Fundus photo: 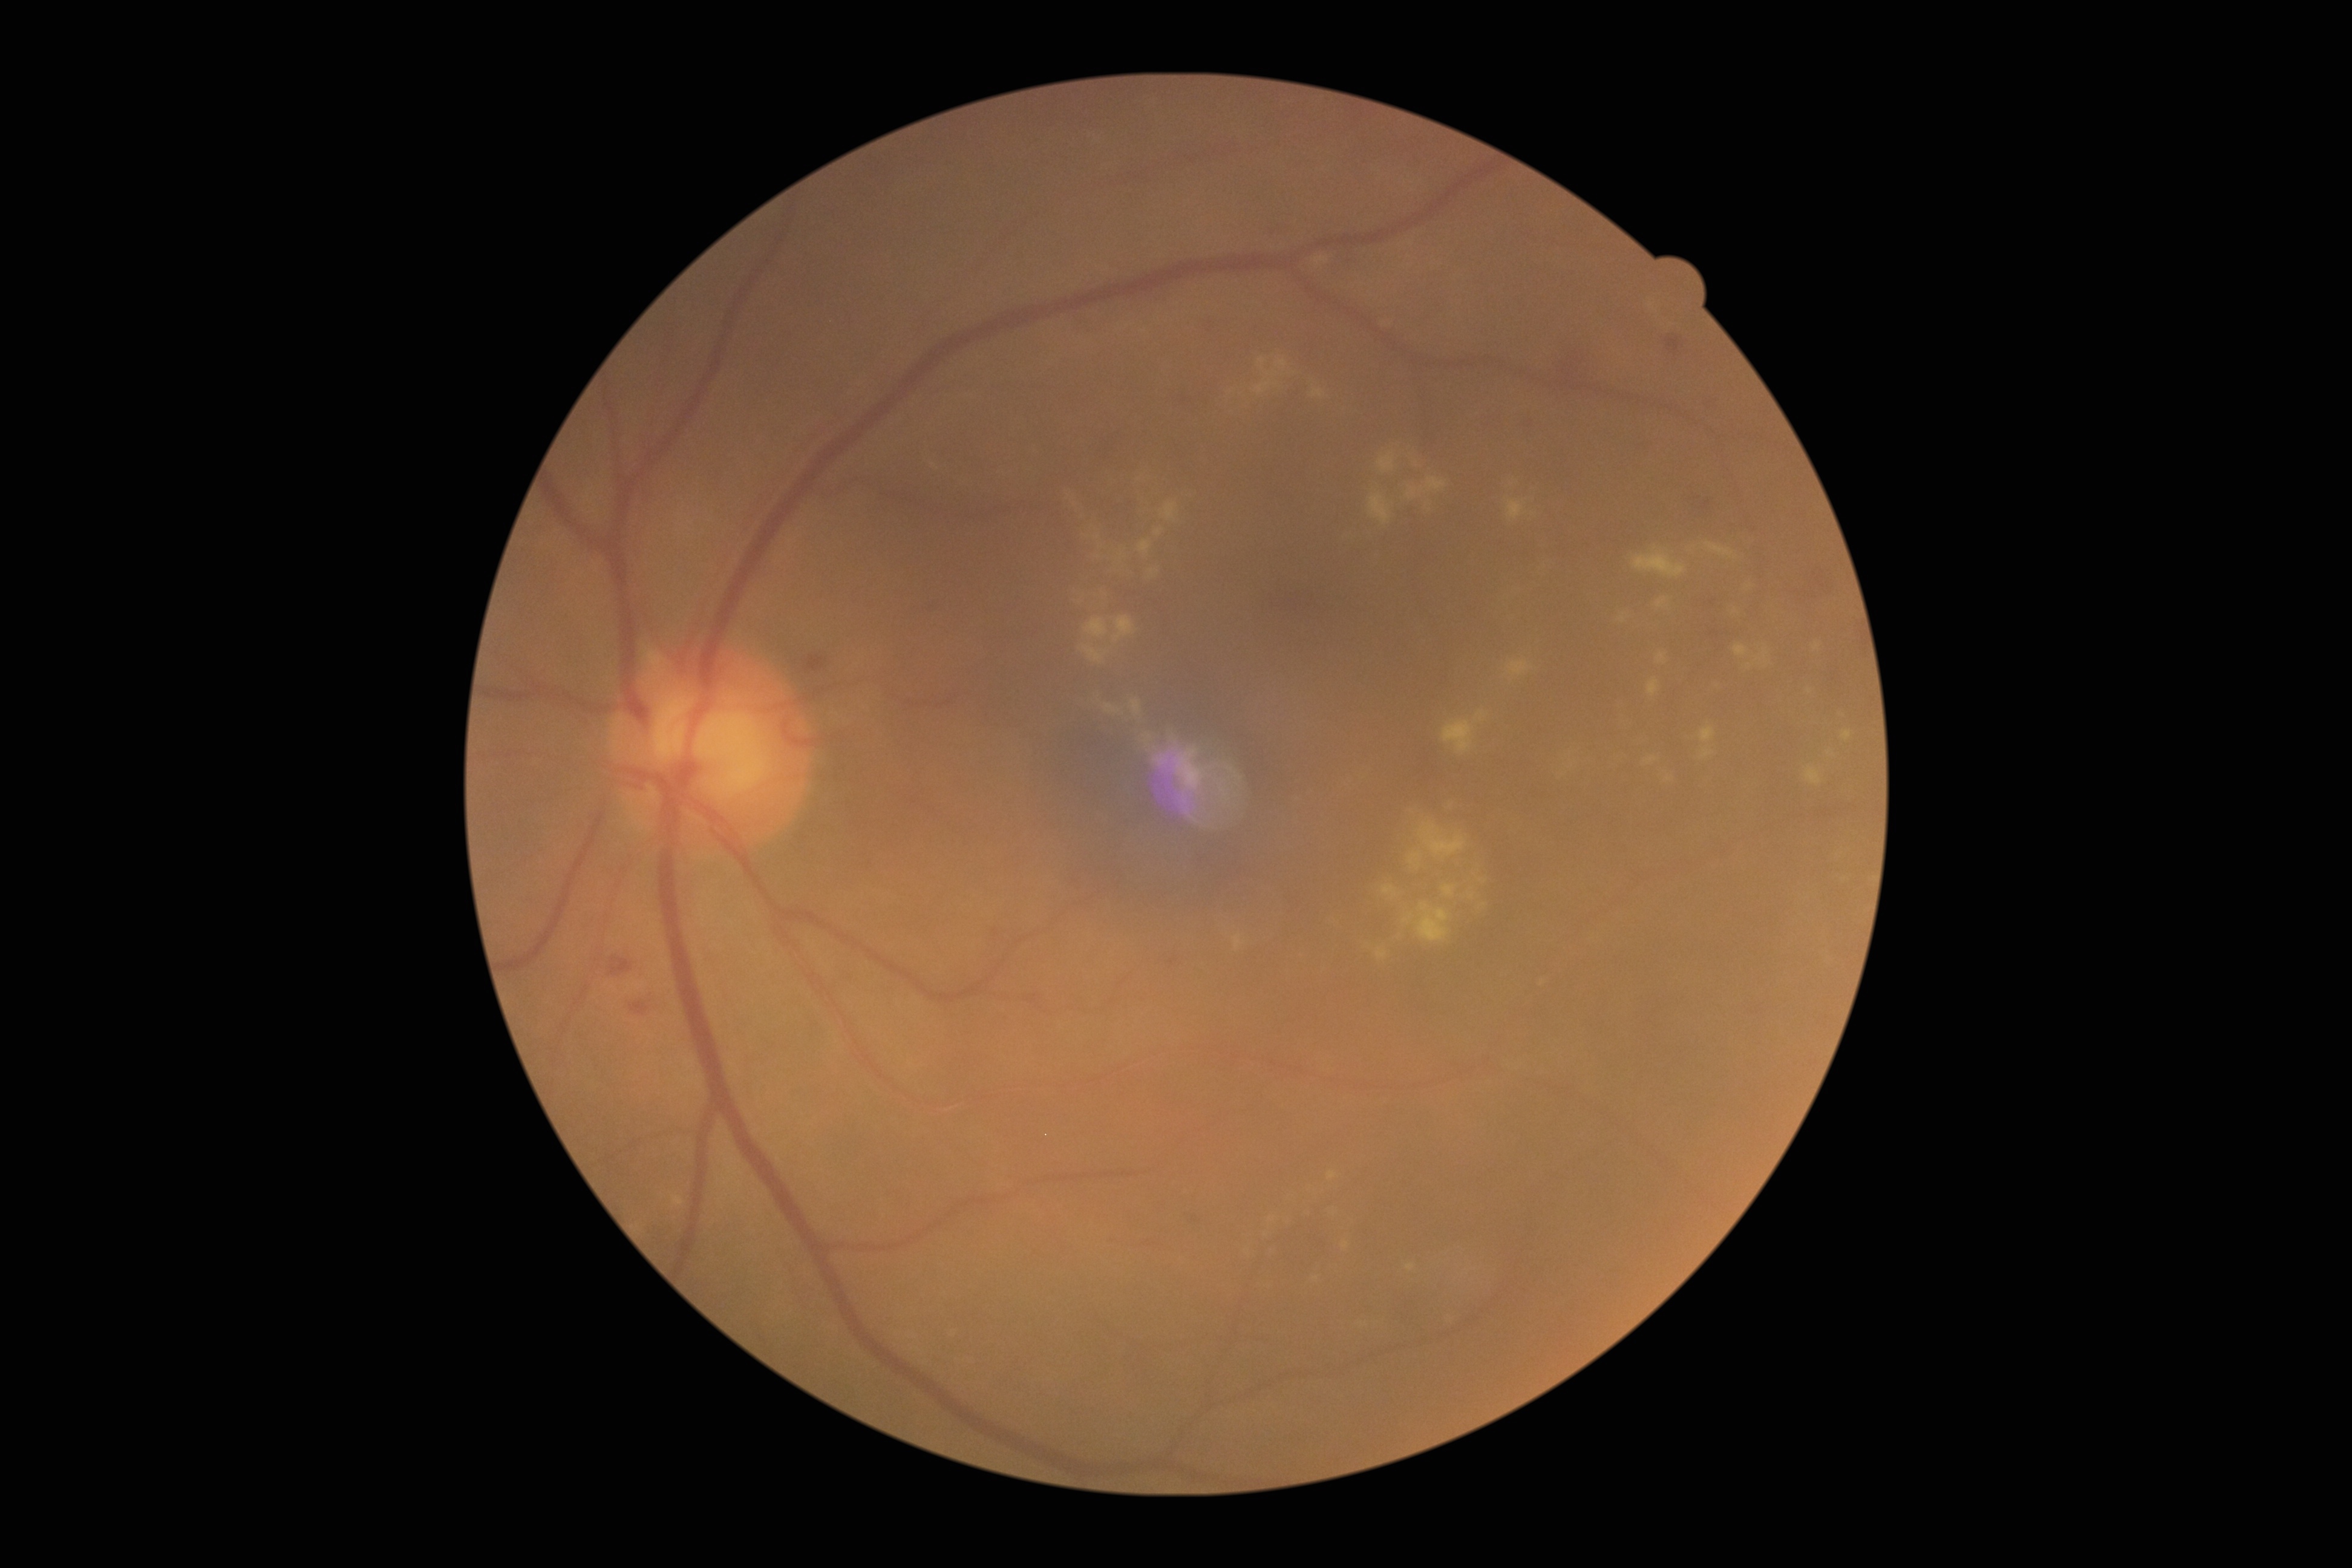
Findings:
- retinopathy grade: 2 (moderate NPDR)